2048x1536px:
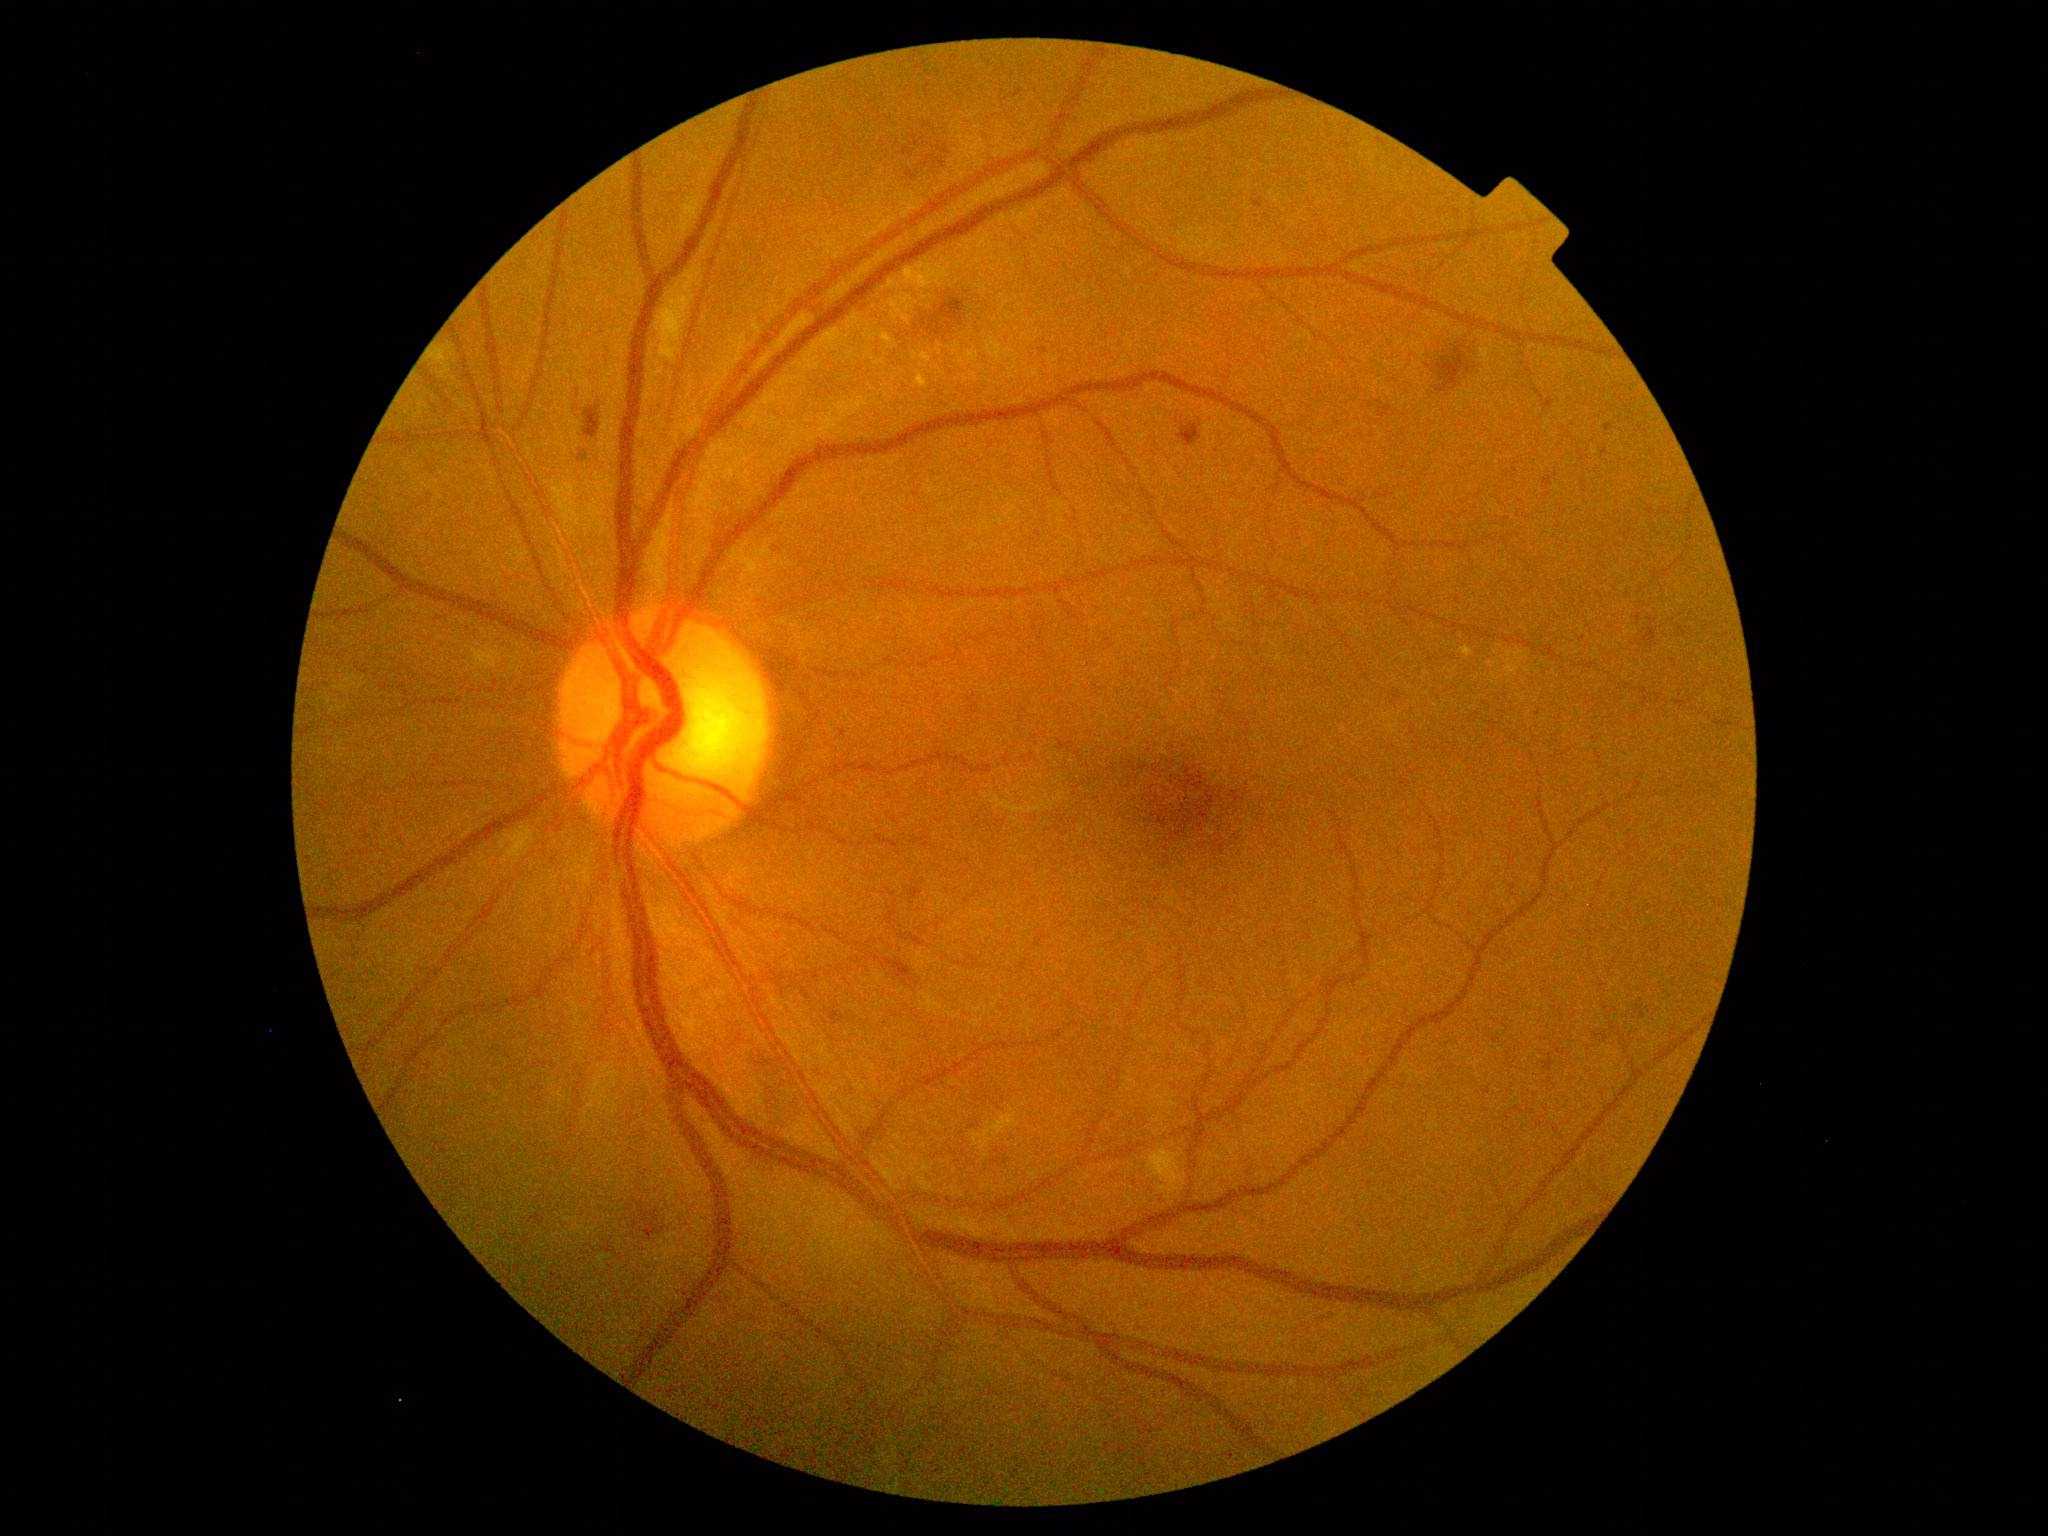

DR severity = moderate NPDR (grade 2) | DR class = non-proliferative diabetic retinopathy.